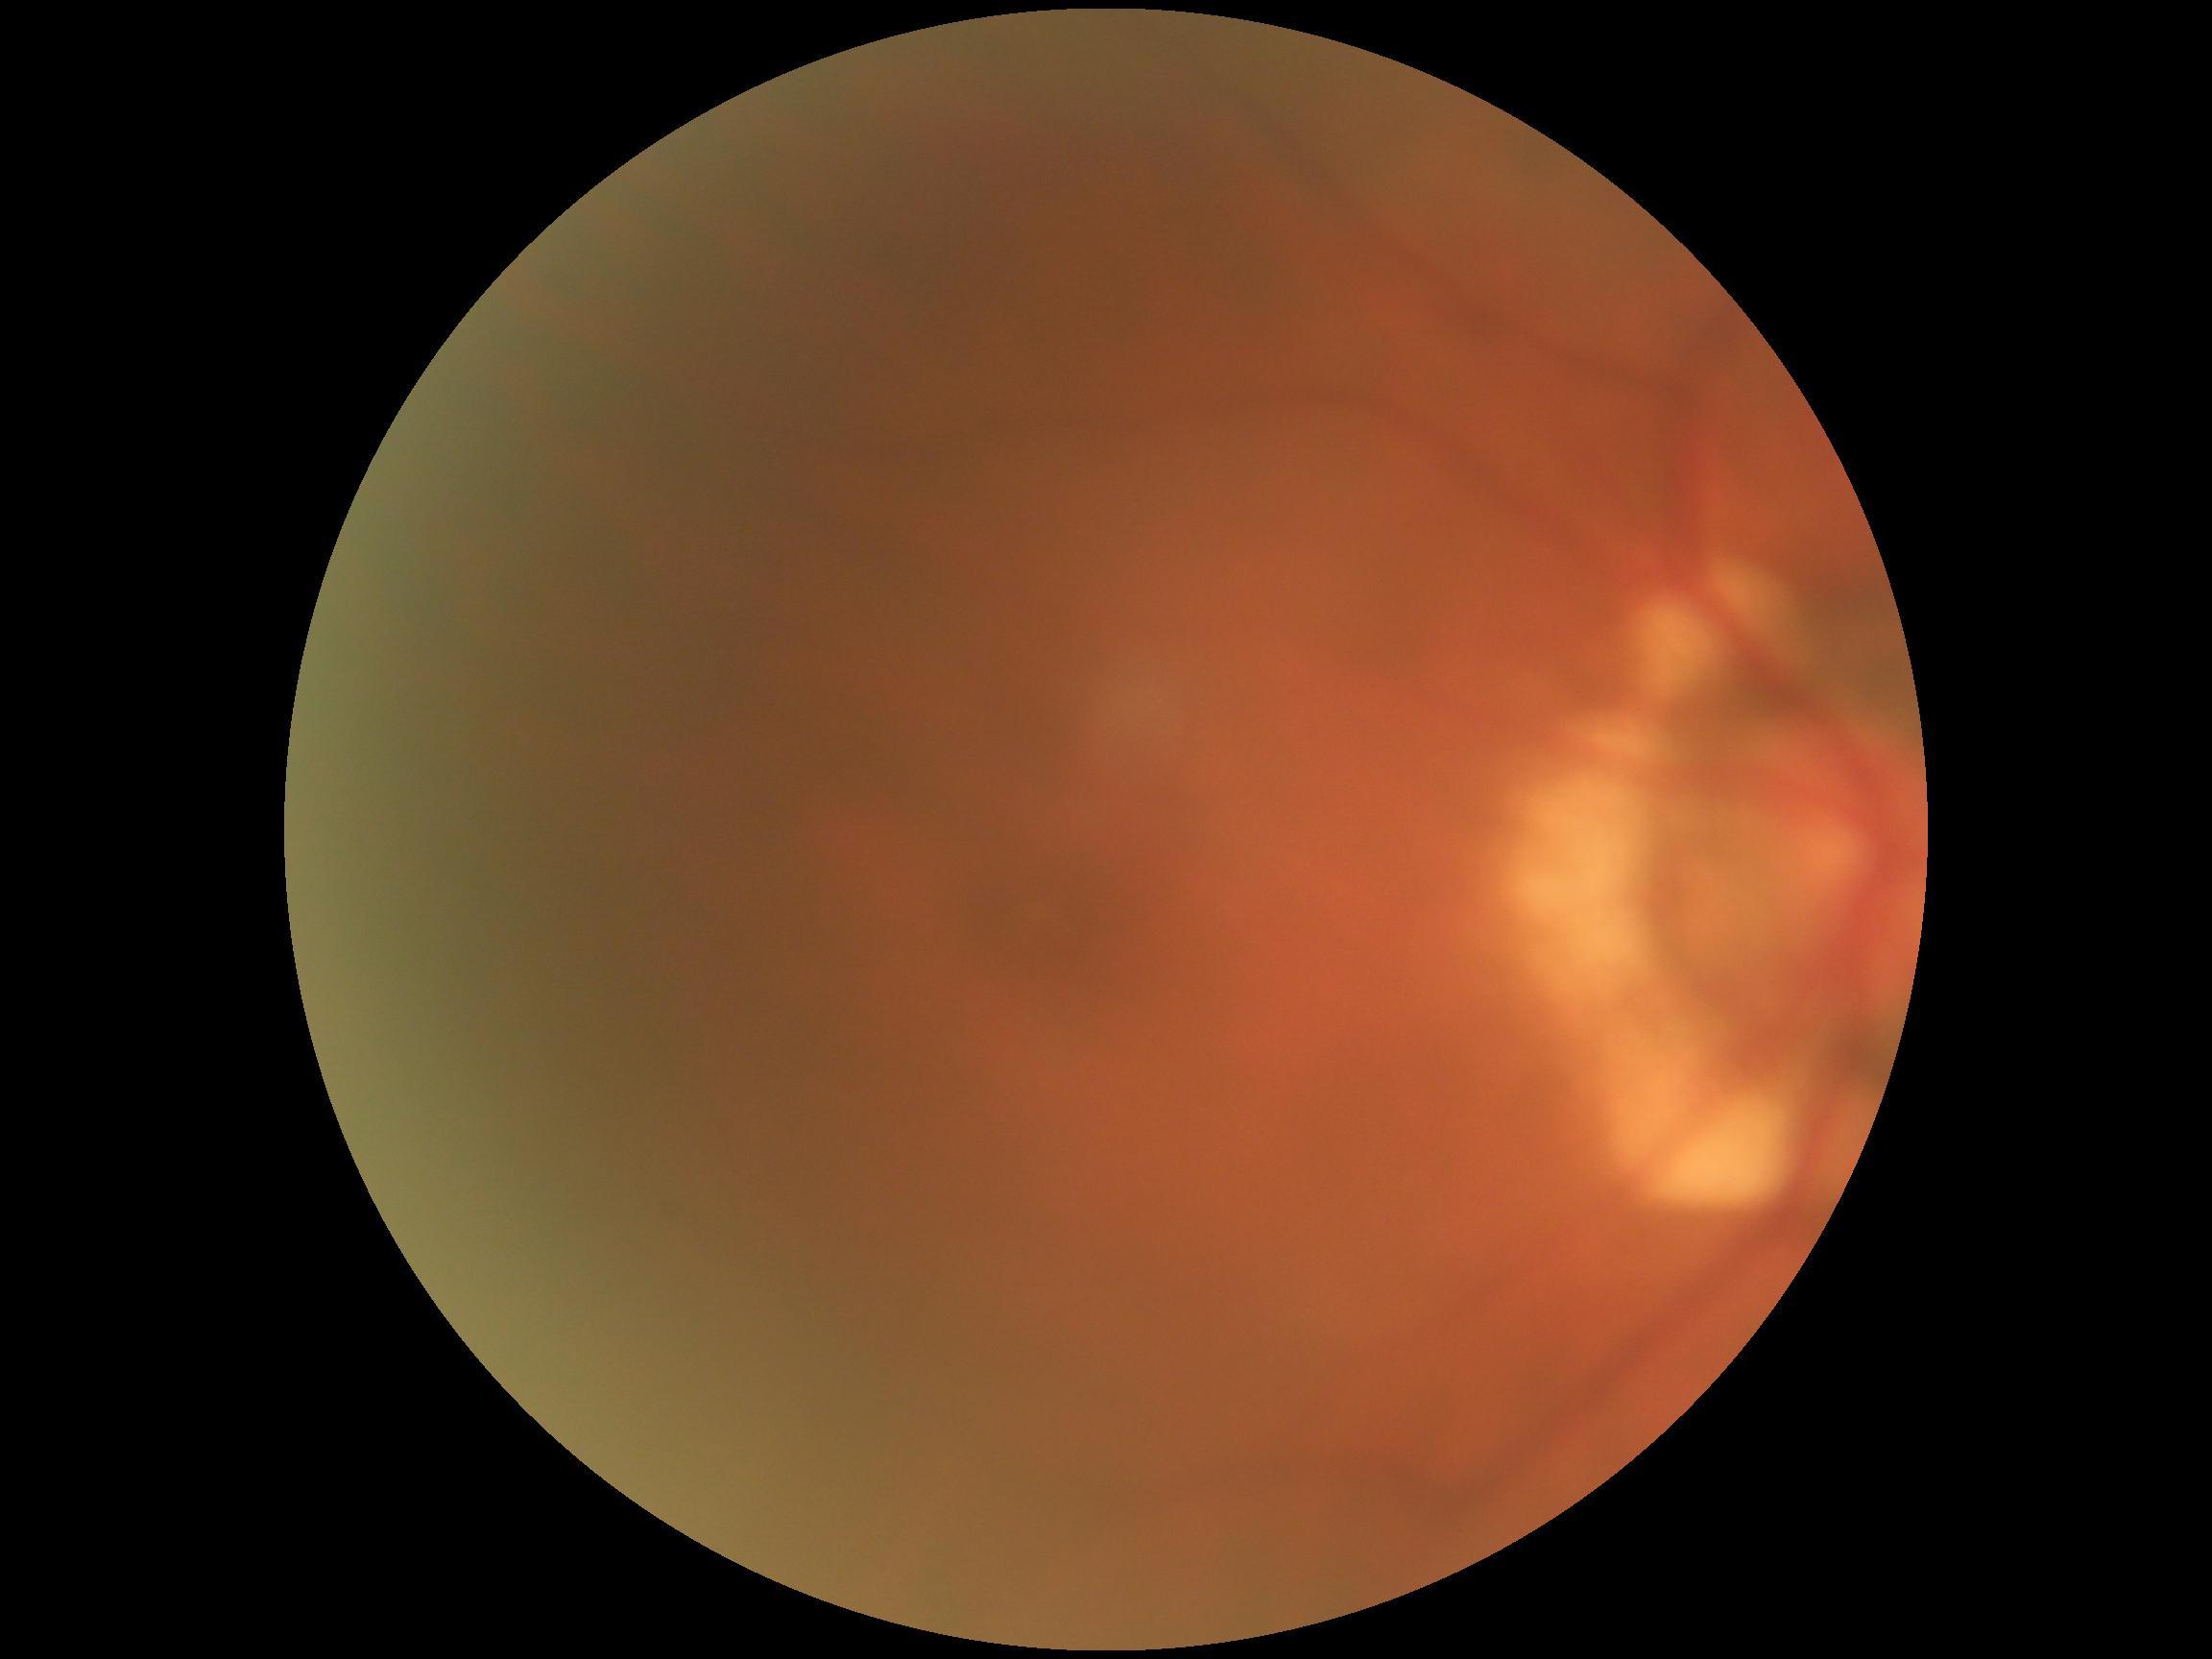
* diabetic retinopathy (DR): 0/4
* DR impression: no signs of DR